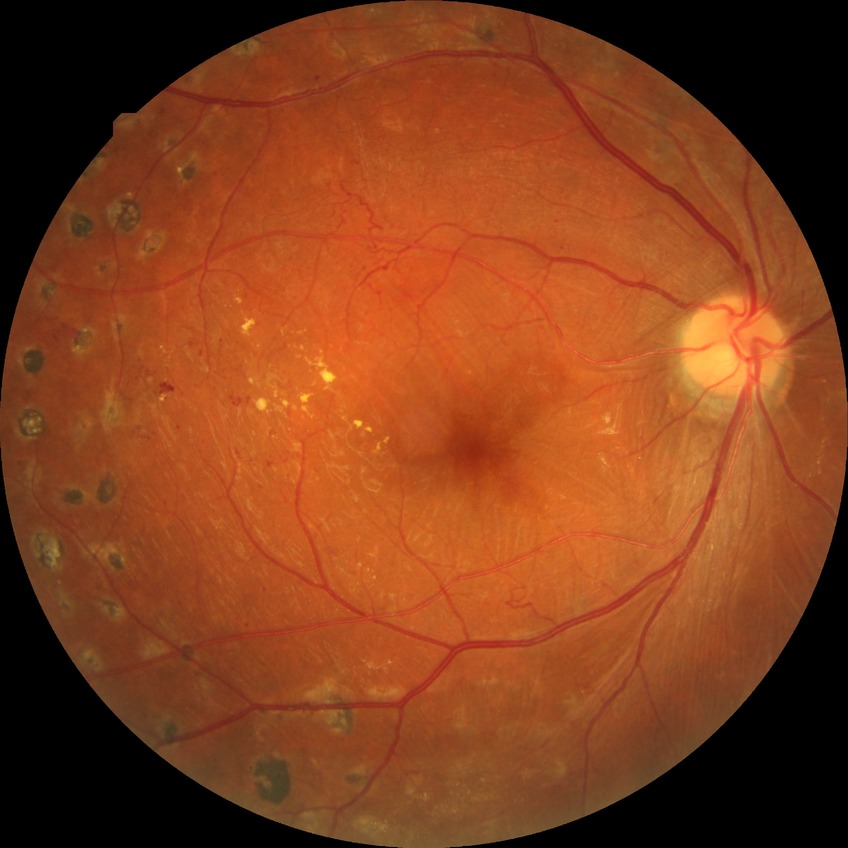

diabetic retinopathy (DR): PDR (proliferative diabetic retinopathy).